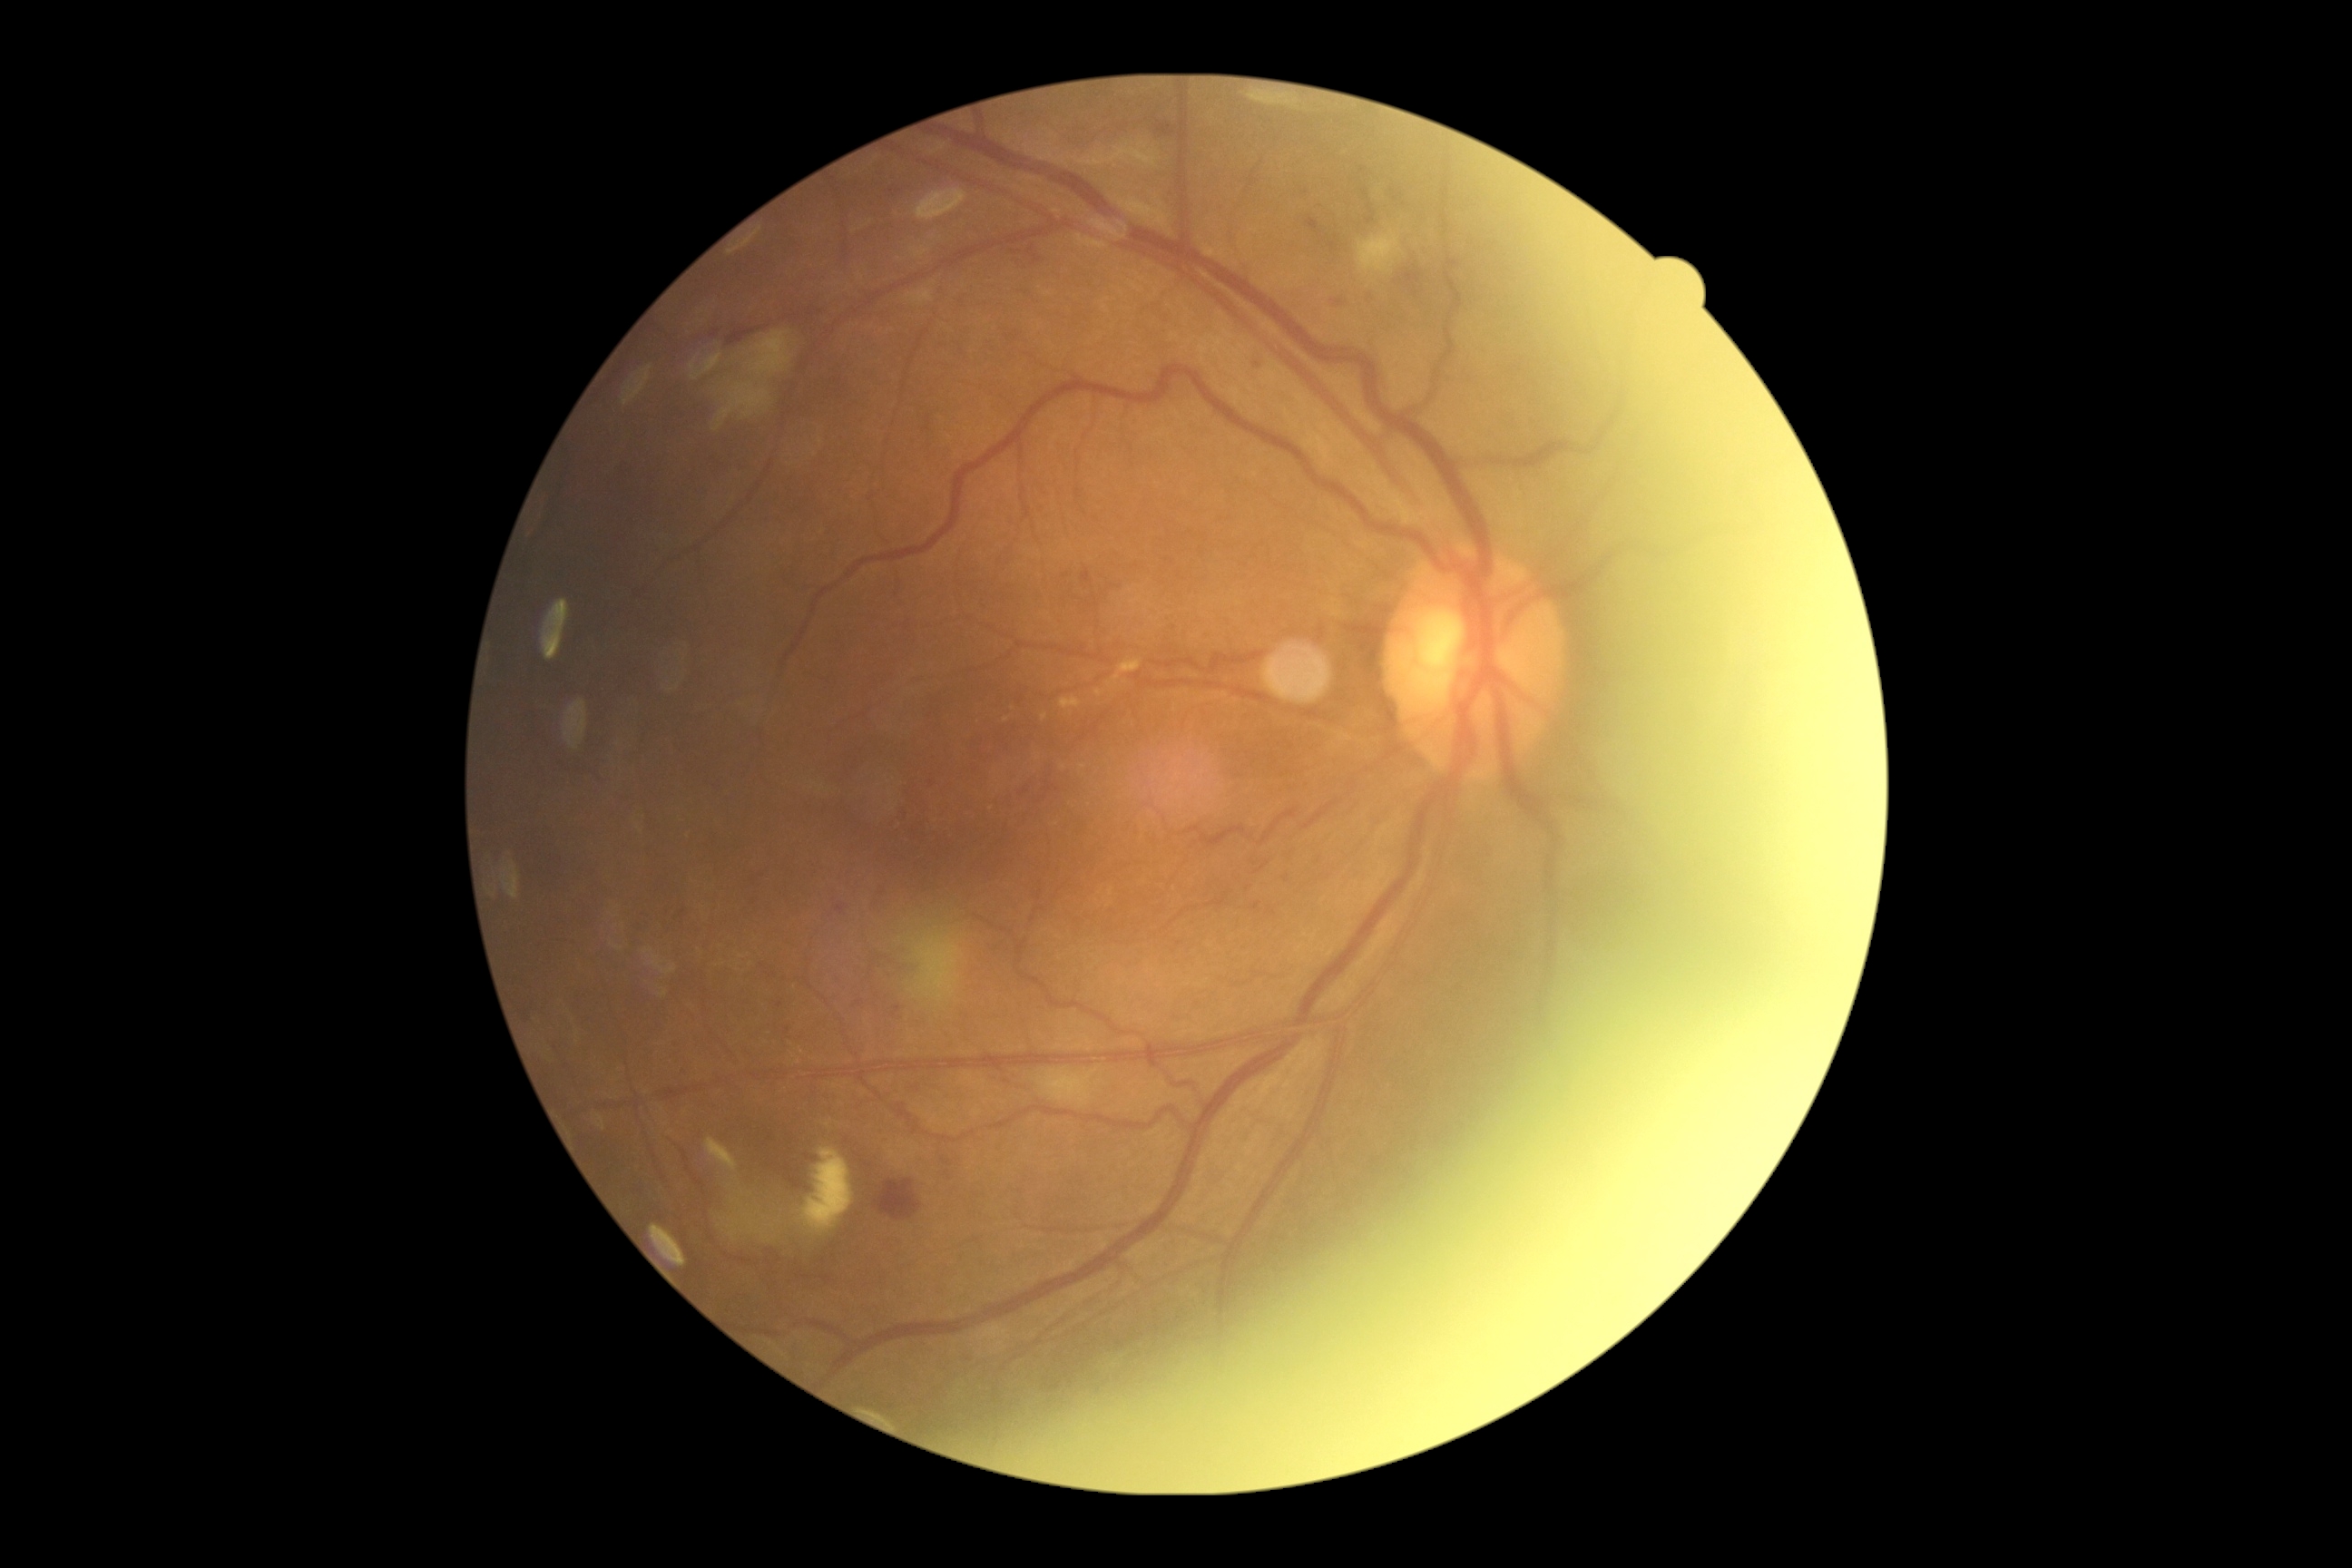

DR grade: 2.